1932x1910px. 45° field of view: 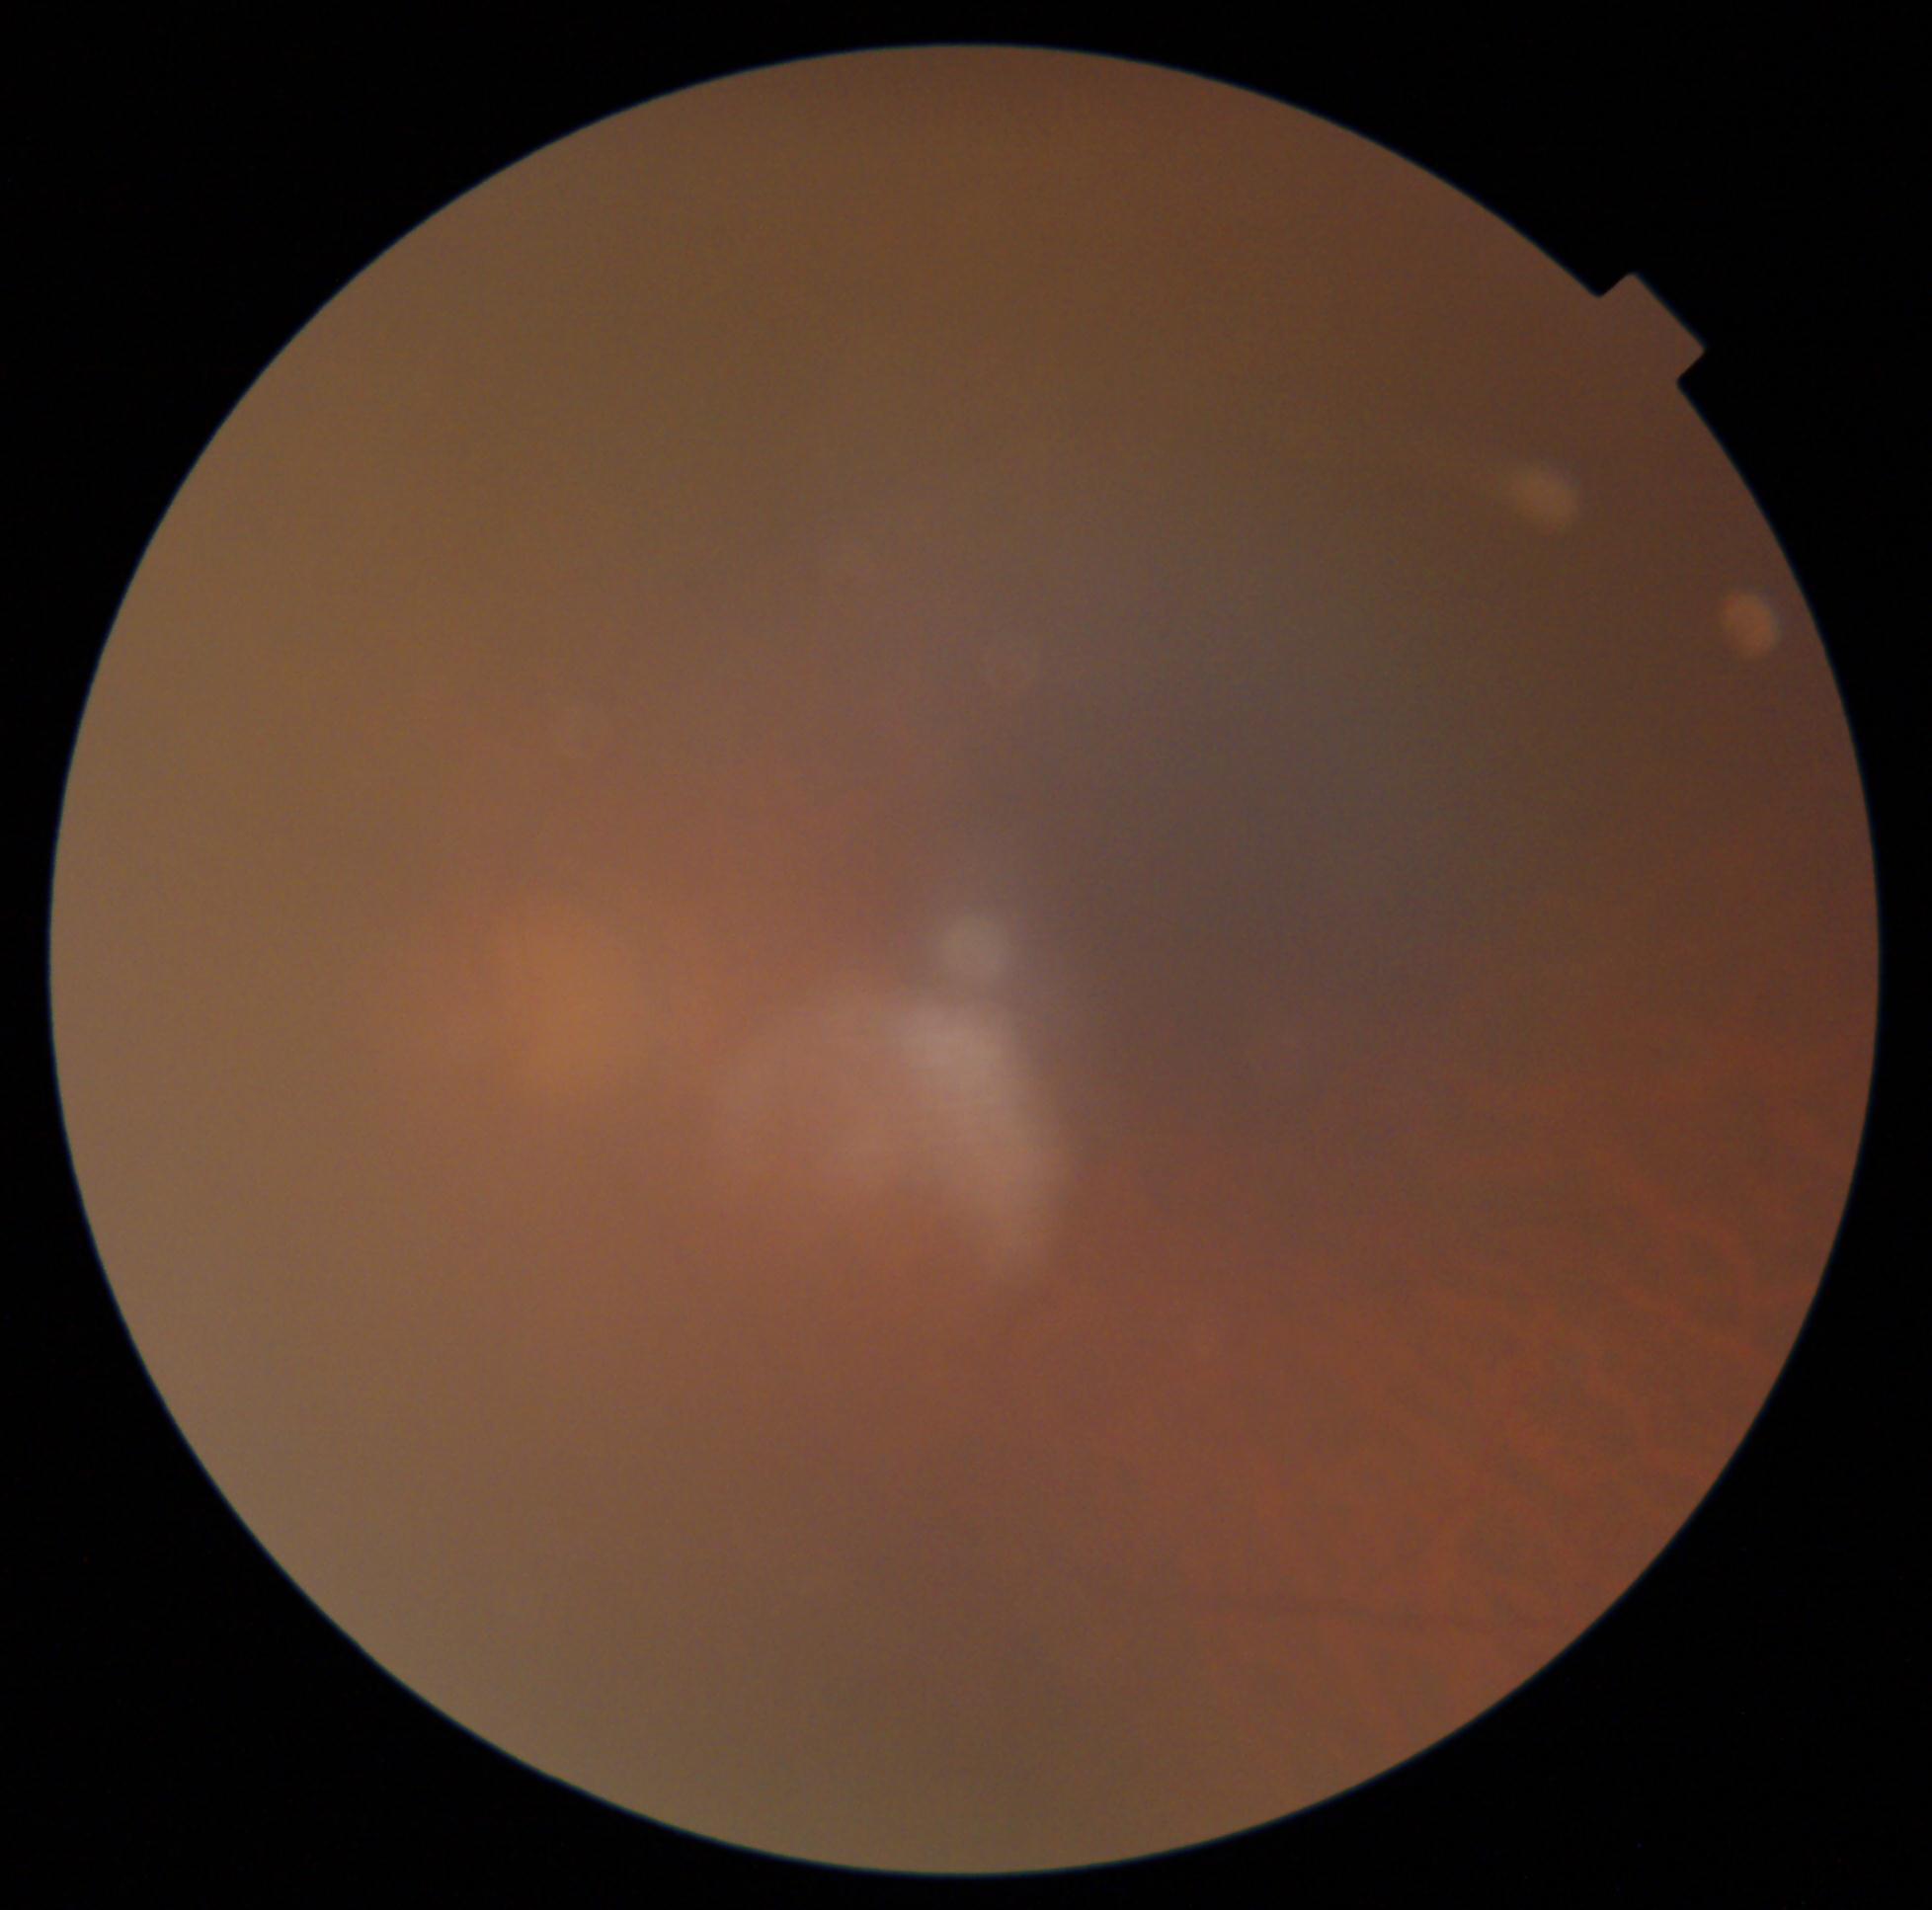
Diabetic retinopathy (DR) is ungradable.